Ultra-widefield fundus photograph: 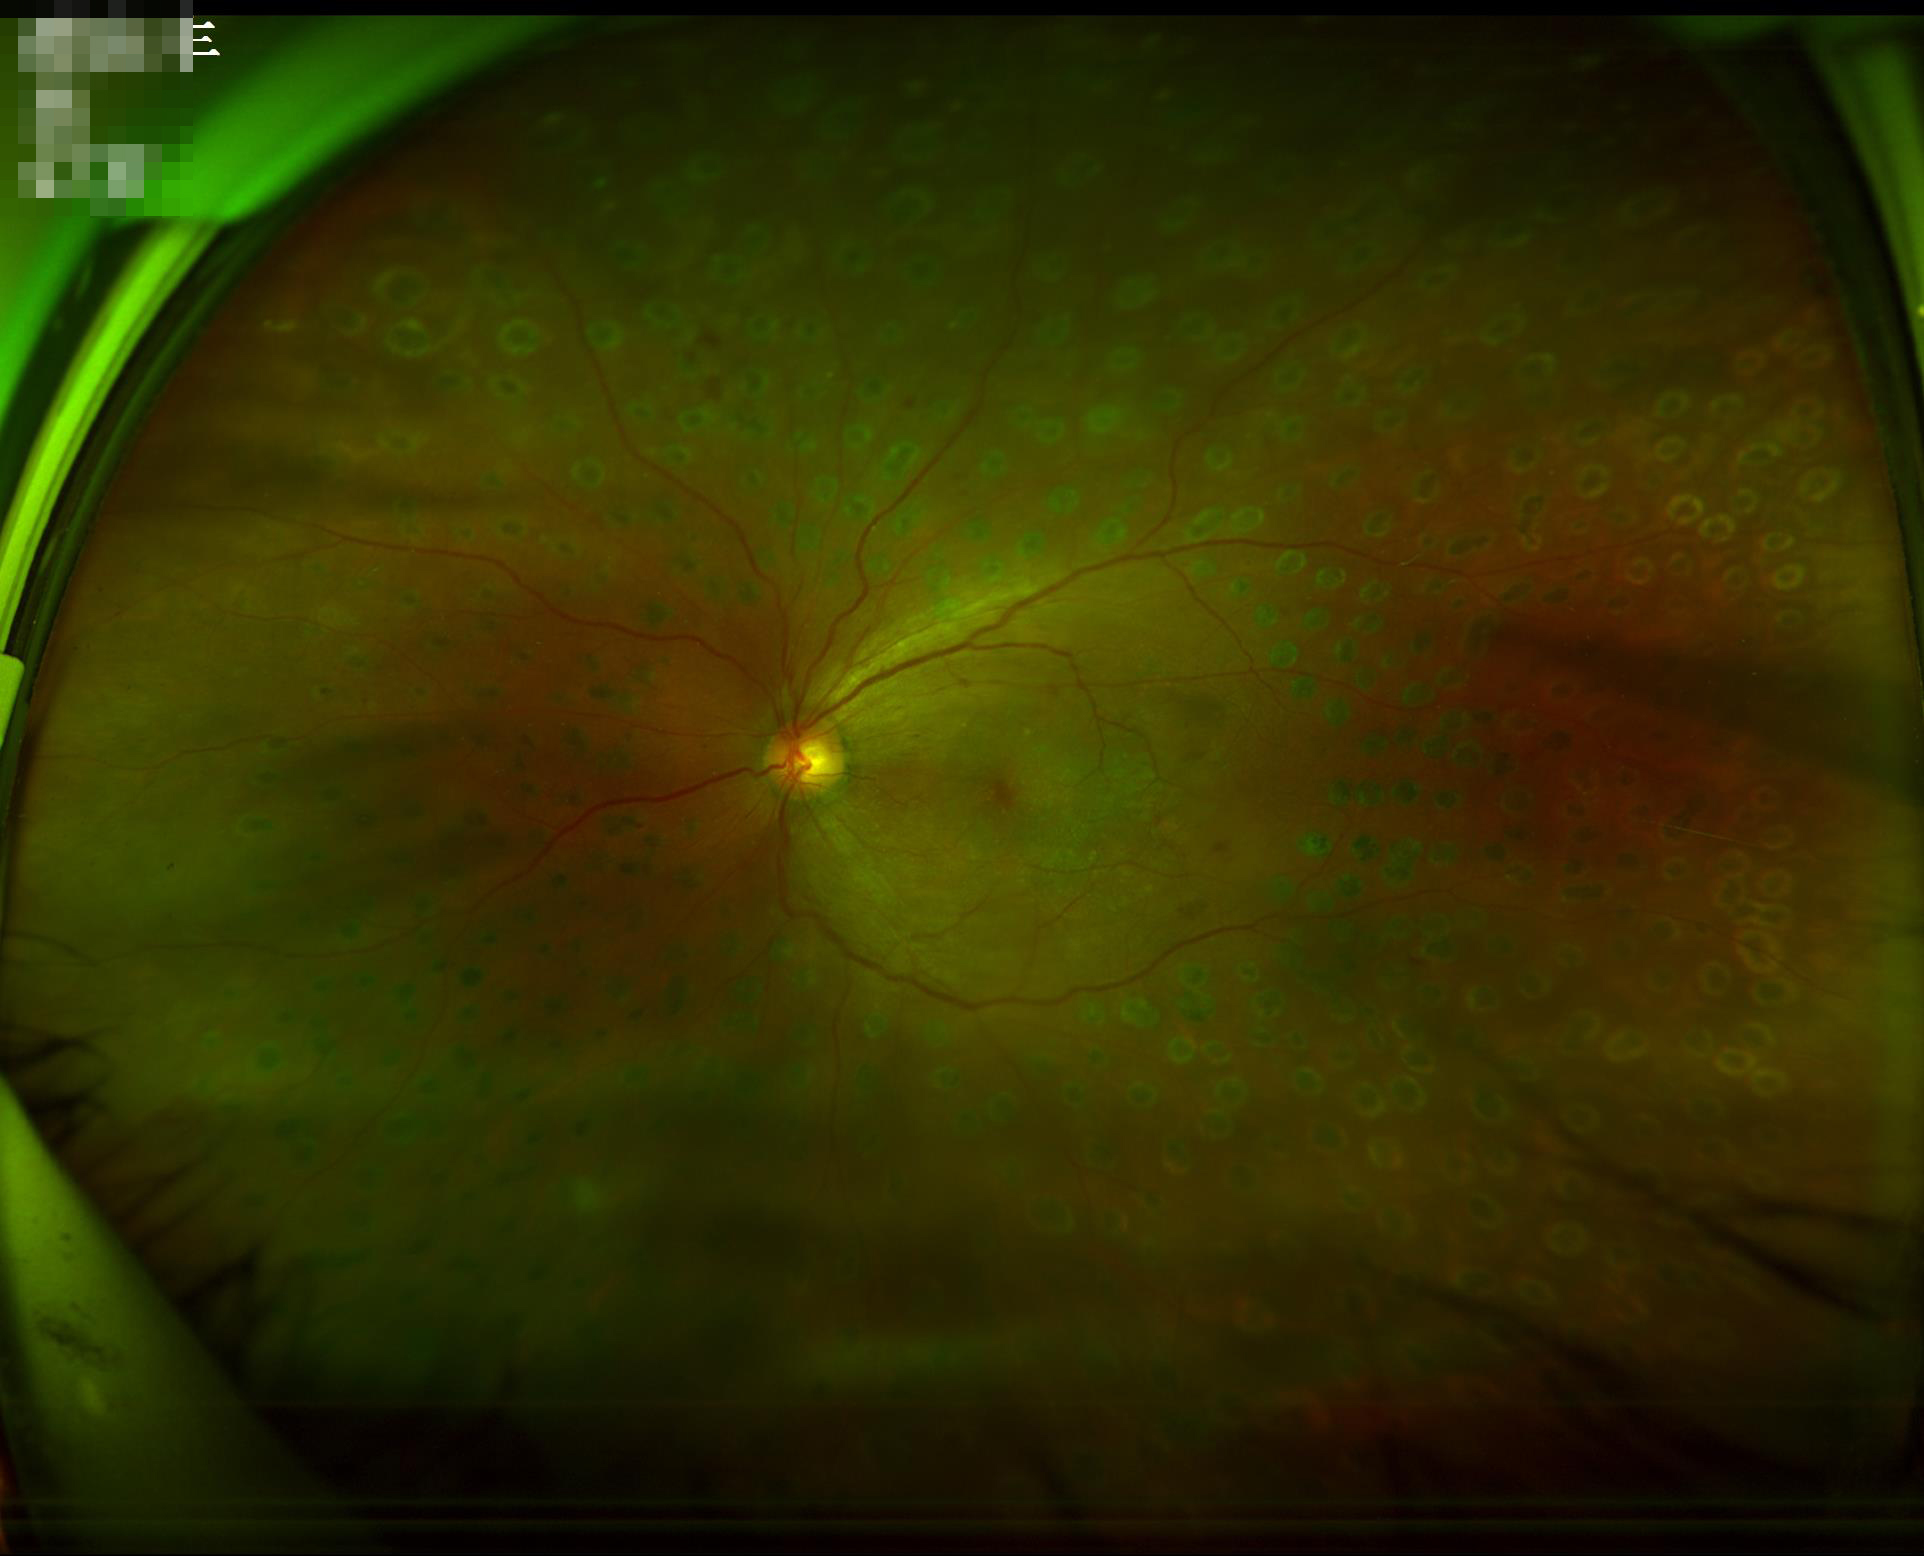

Quality grading: contrast: vessels and details readily distinguishable; illumination/color: uniform, no color cast; overall: good and suitable for diagnostic use; focus: out of focus, structures indistinct.